NIDEK AFC-230 fundus camera — 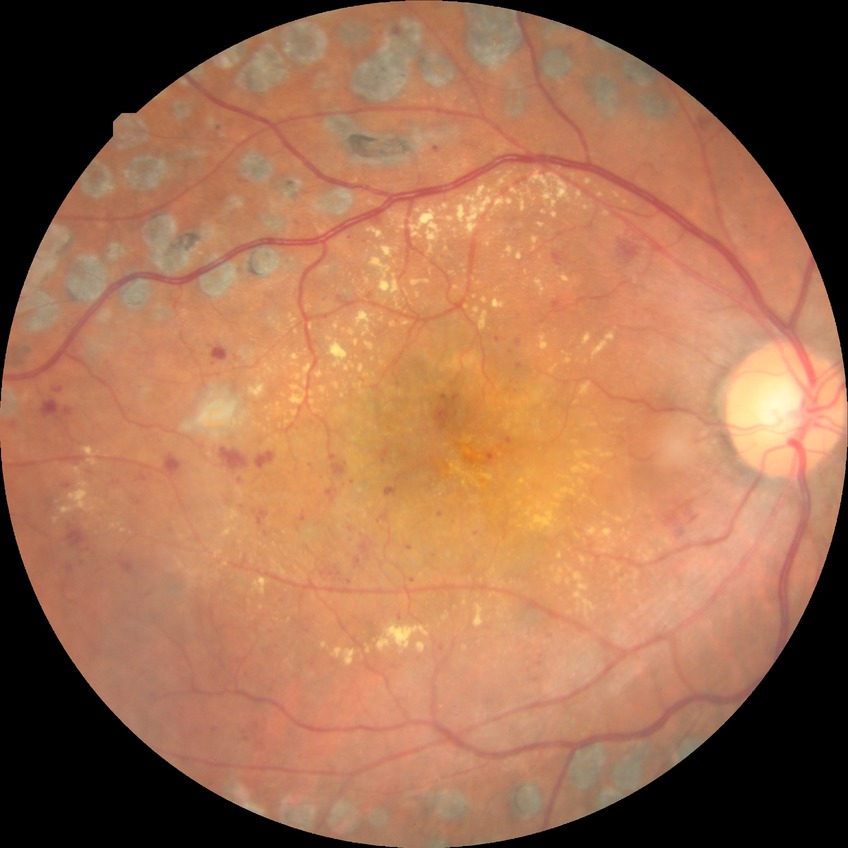
Findings:
• modified Davis grading: proliferative diabetic retinopathy